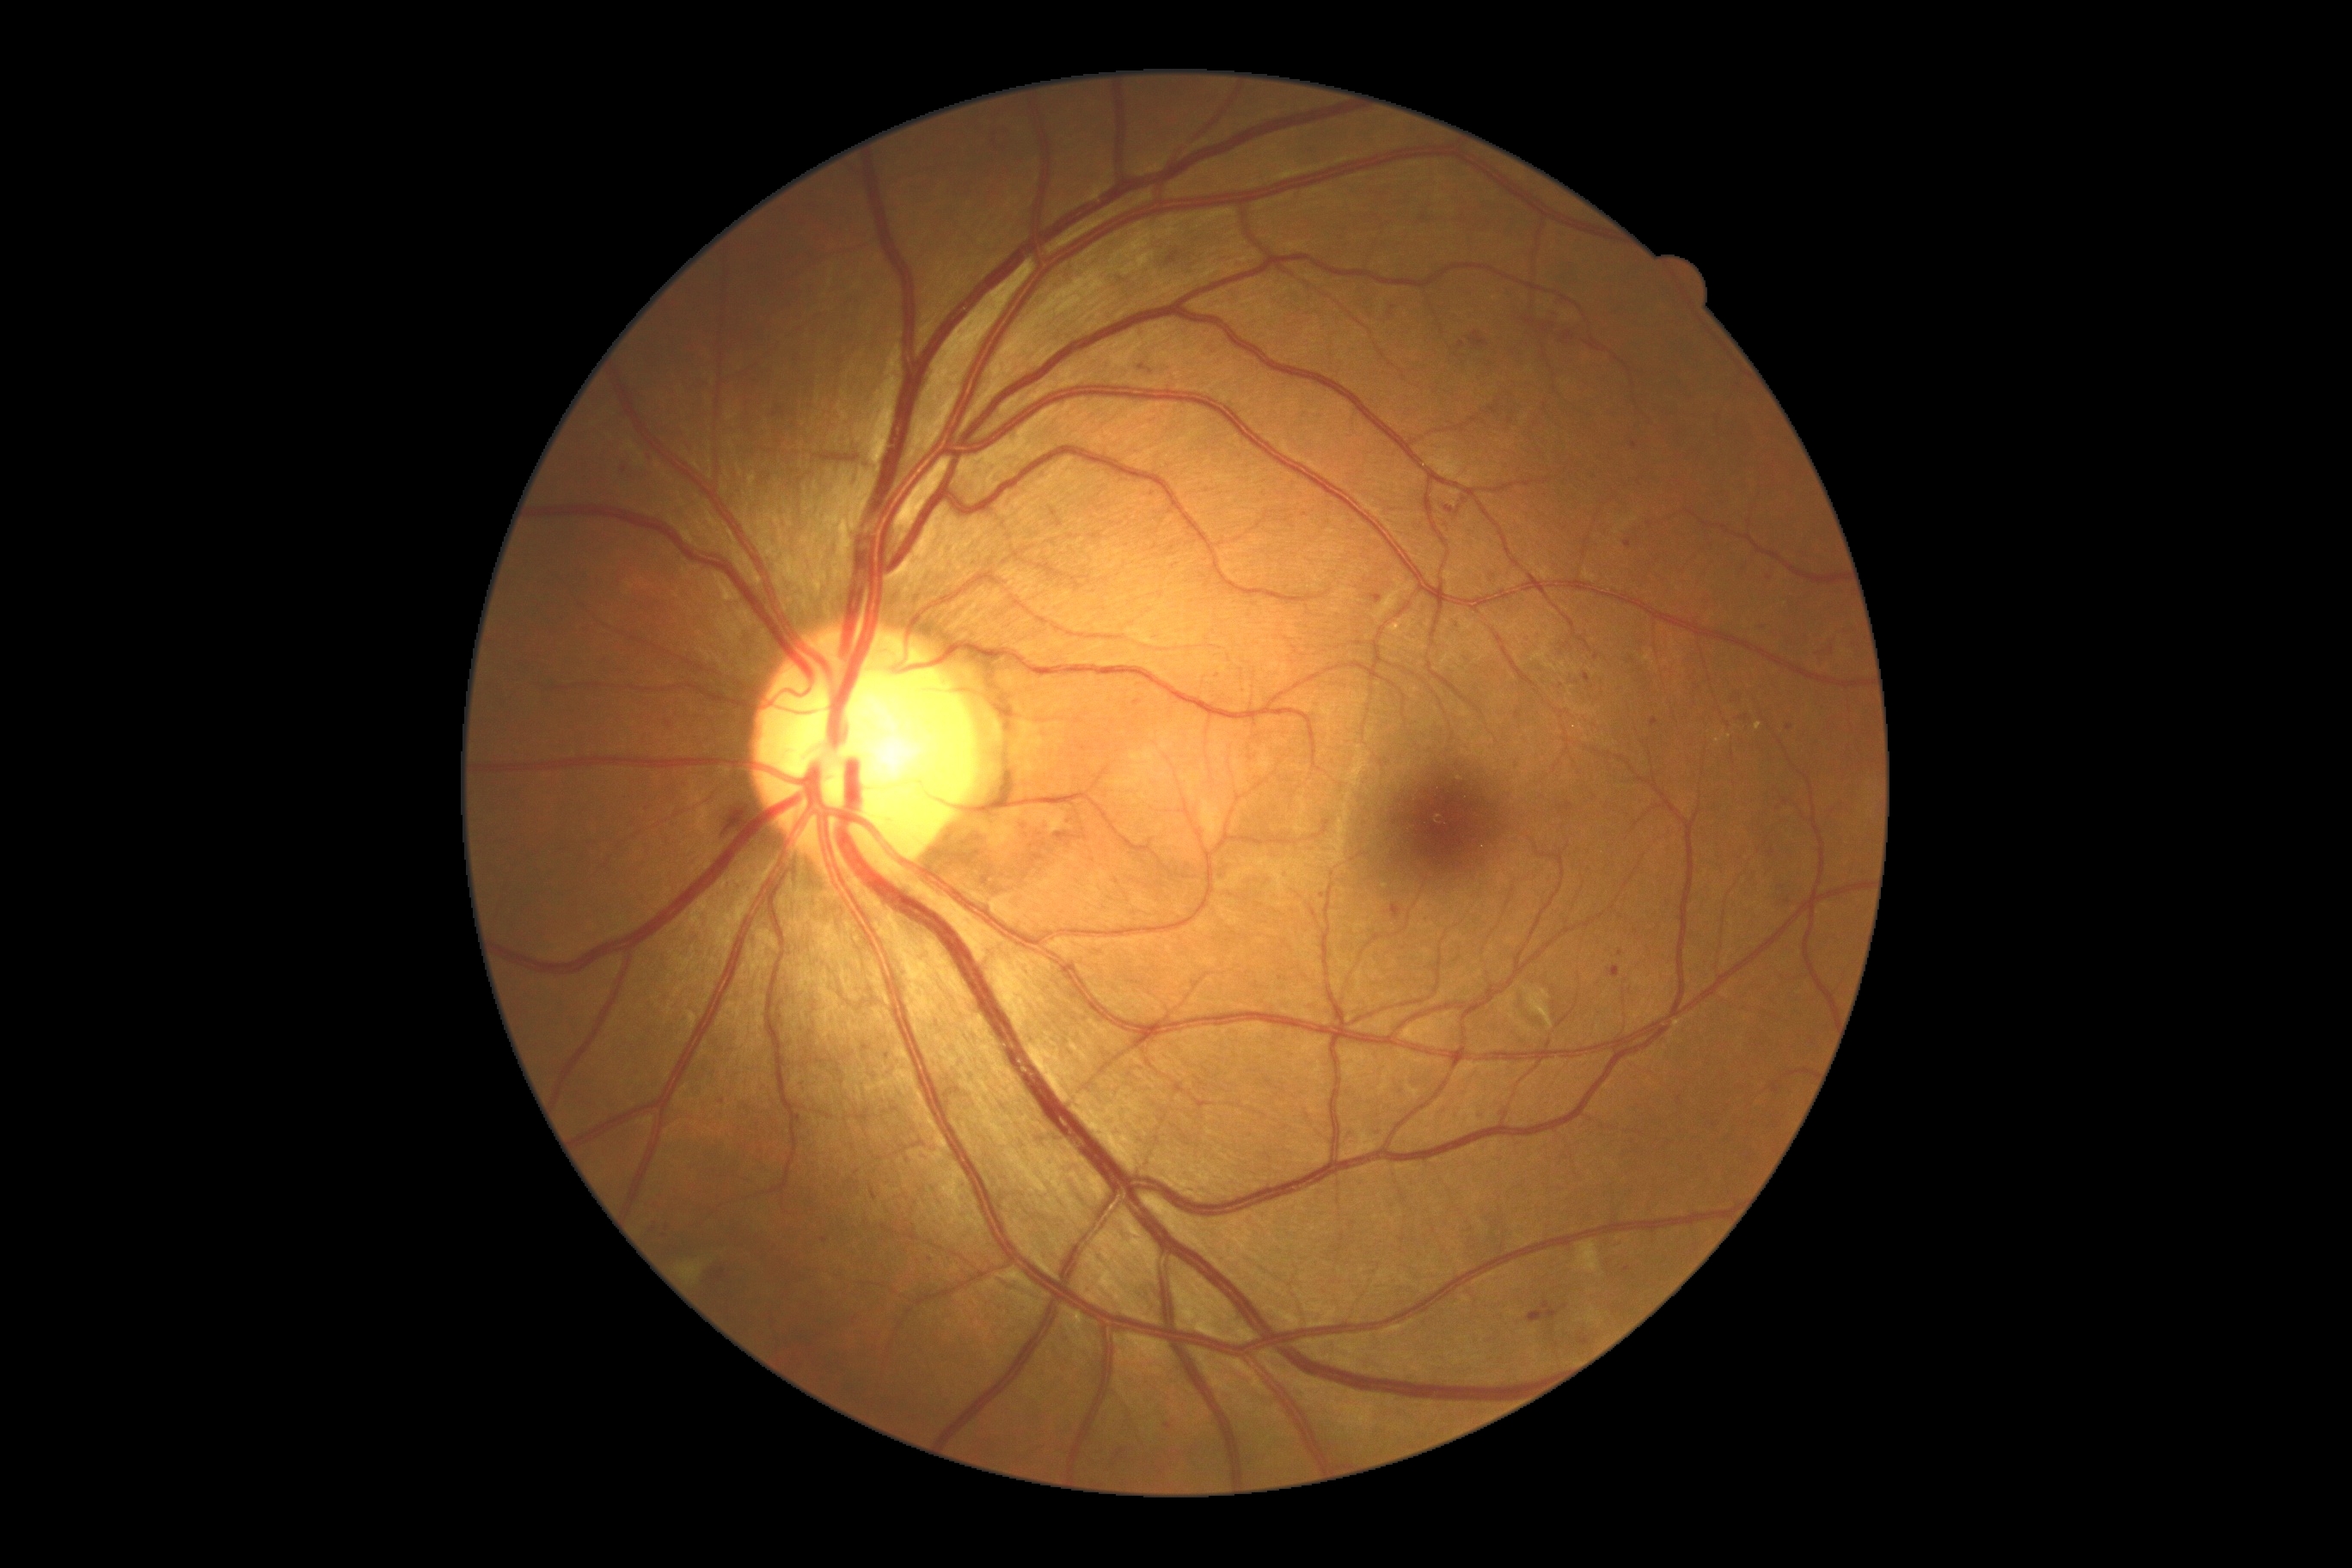 DR: grade 2 (moderate NPDR).
MAs include those at 1454, 623, 1462, 630; 1117, 1450, 1127, 1459; 1632, 443, 1638, 451; 1469, 333, 1488, 350; 793, 1113, 802, 1127; 1768, 848, 1777, 857; 1607, 967, 1620, 979.
Small MAs near (x=1170, y=511); (x=668, y=1228); (x=1552, y=326); (x=1306, y=515); (x=931, y=1261); (x=1377, y=1135); (x=1519, y=716); (x=1621, y=954).